Acquired with a NIDEK AFC-230:
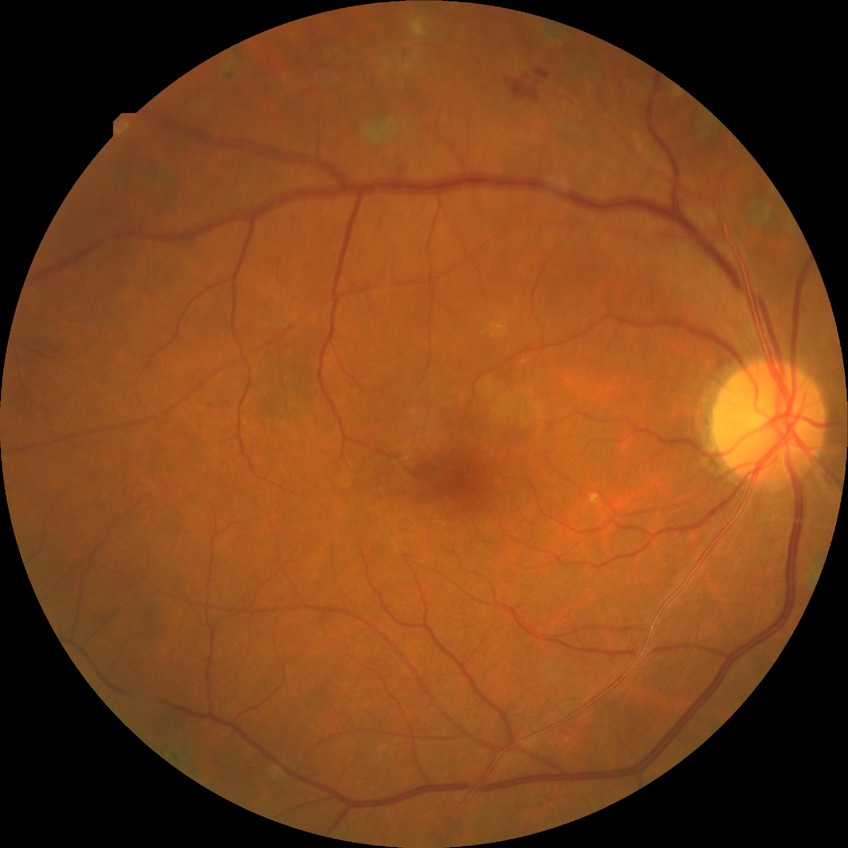
DR stage: PDR.